Captured on a Remidio smartphone fundus camera. Retinal fundus photograph — 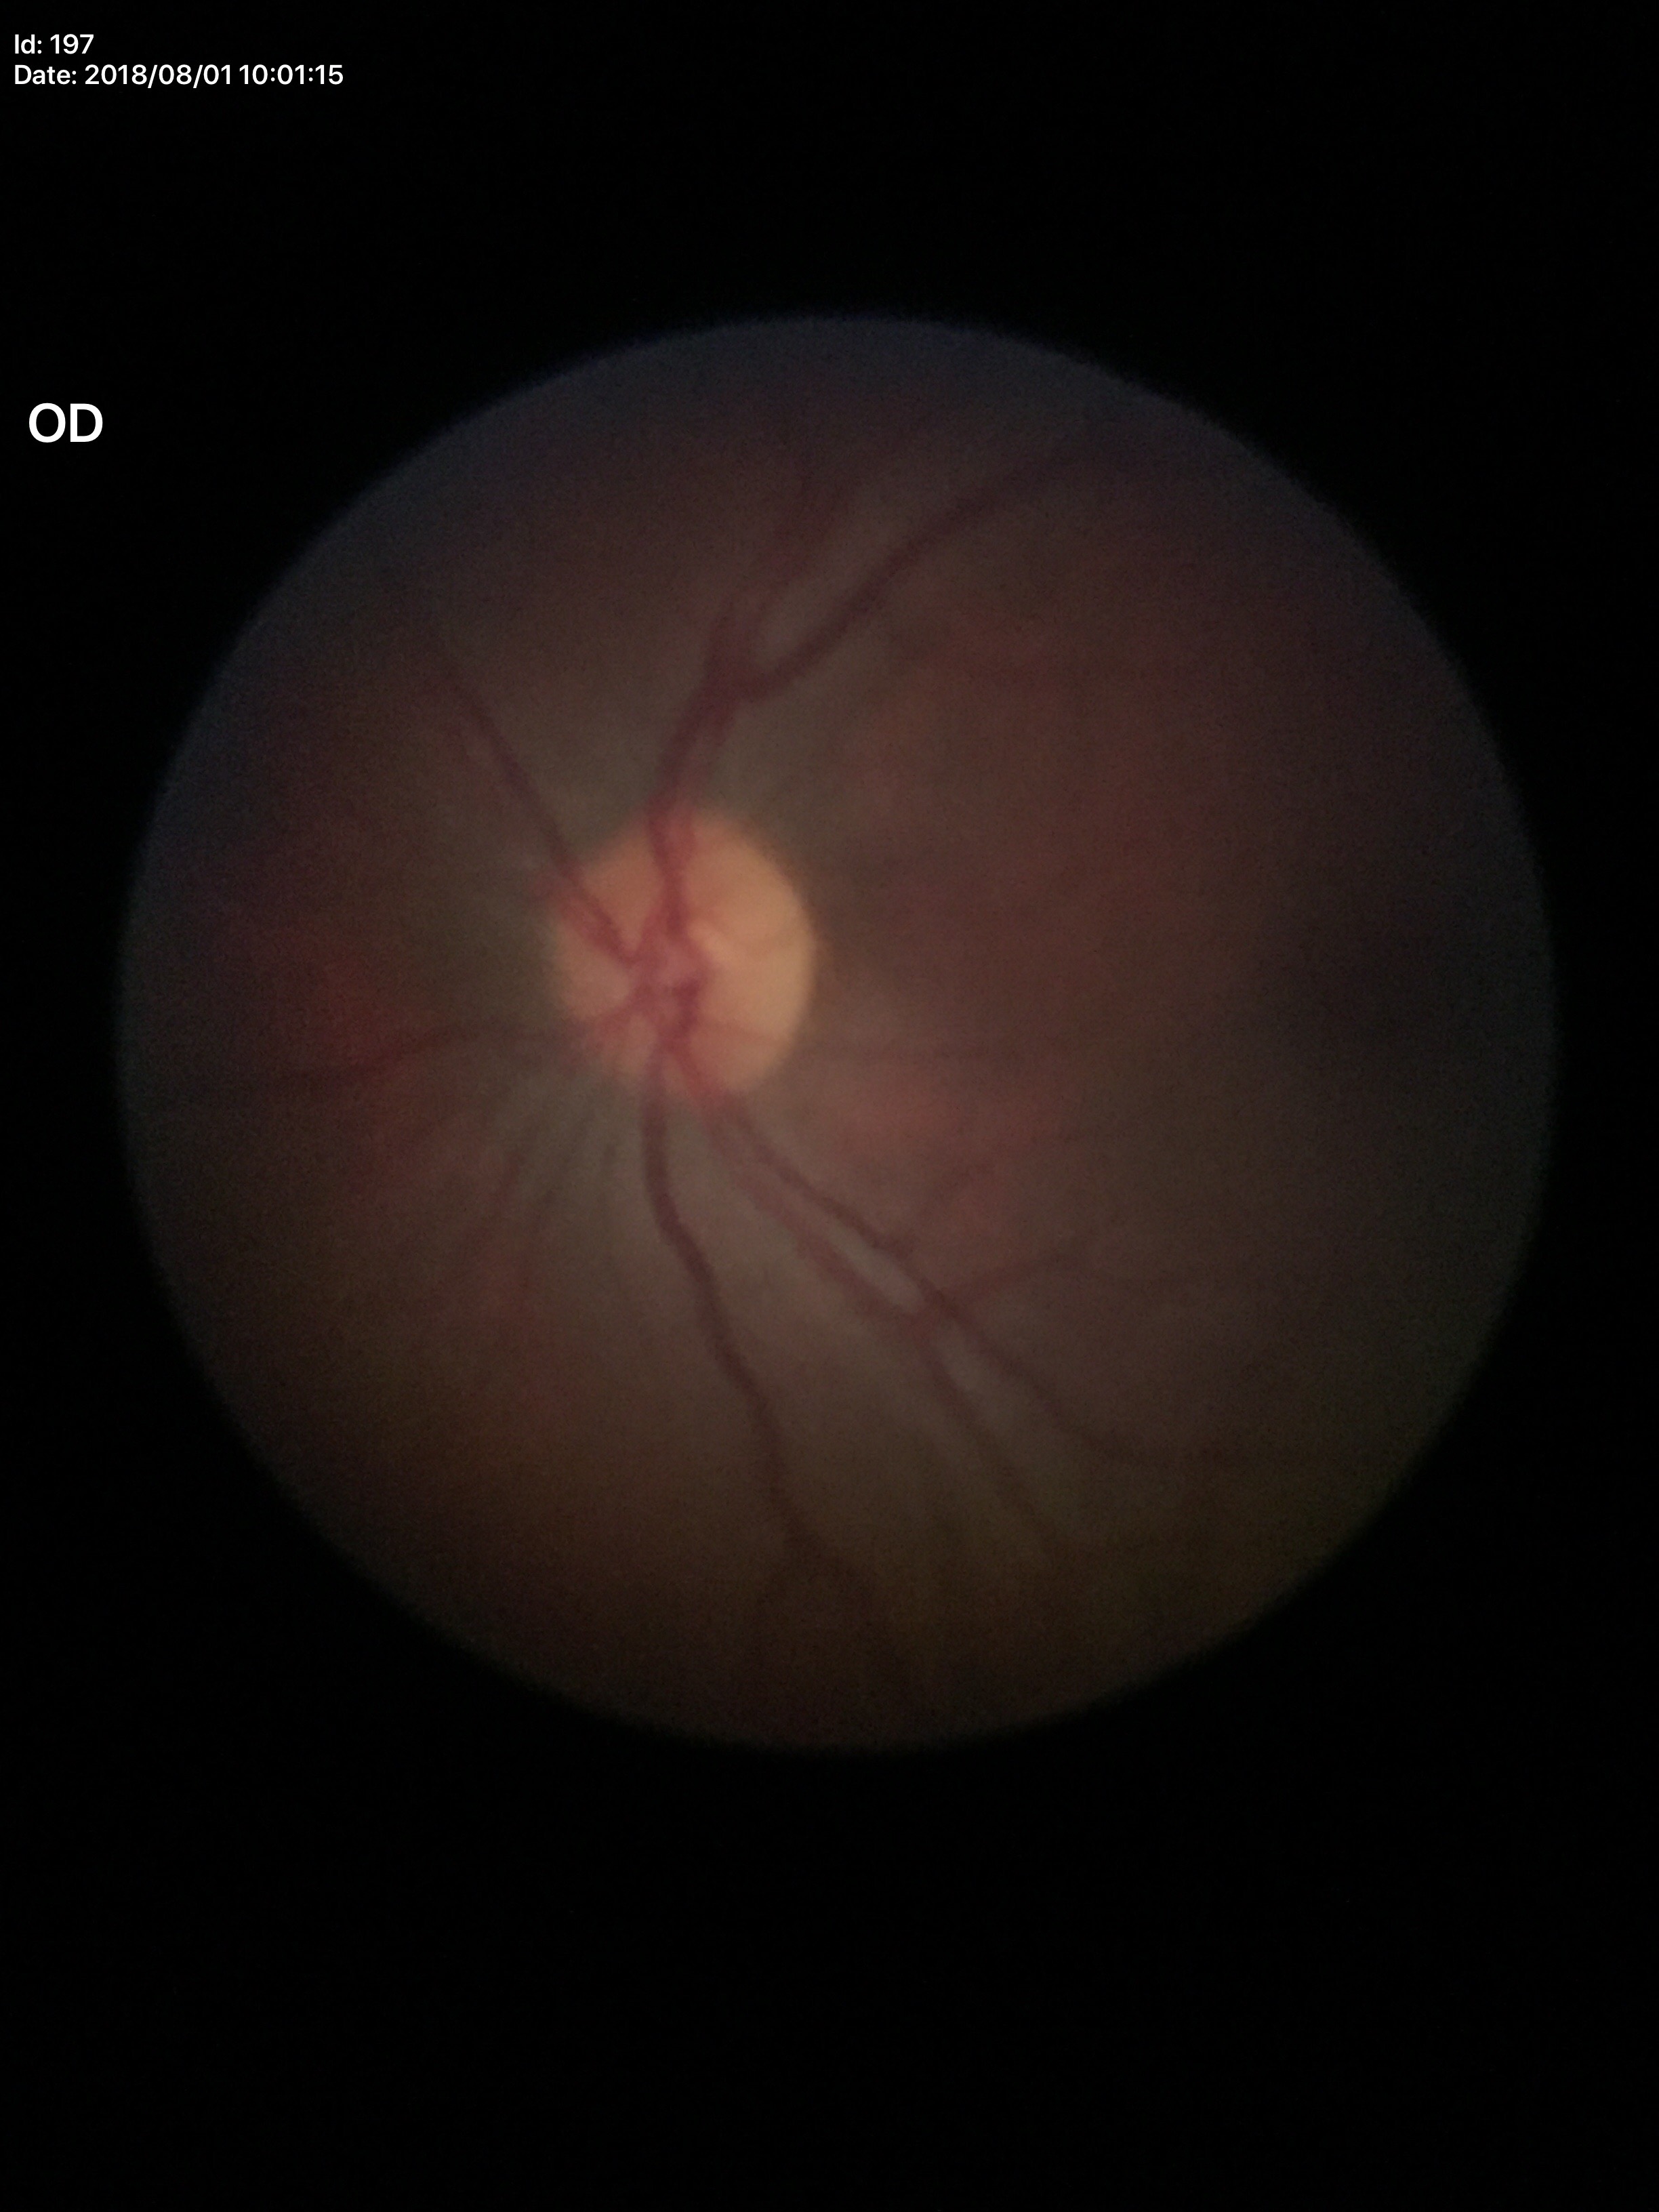

Annotations:
– Glaucoma assessment: no suspicious findings
– VCDR: 0.47